CFP:
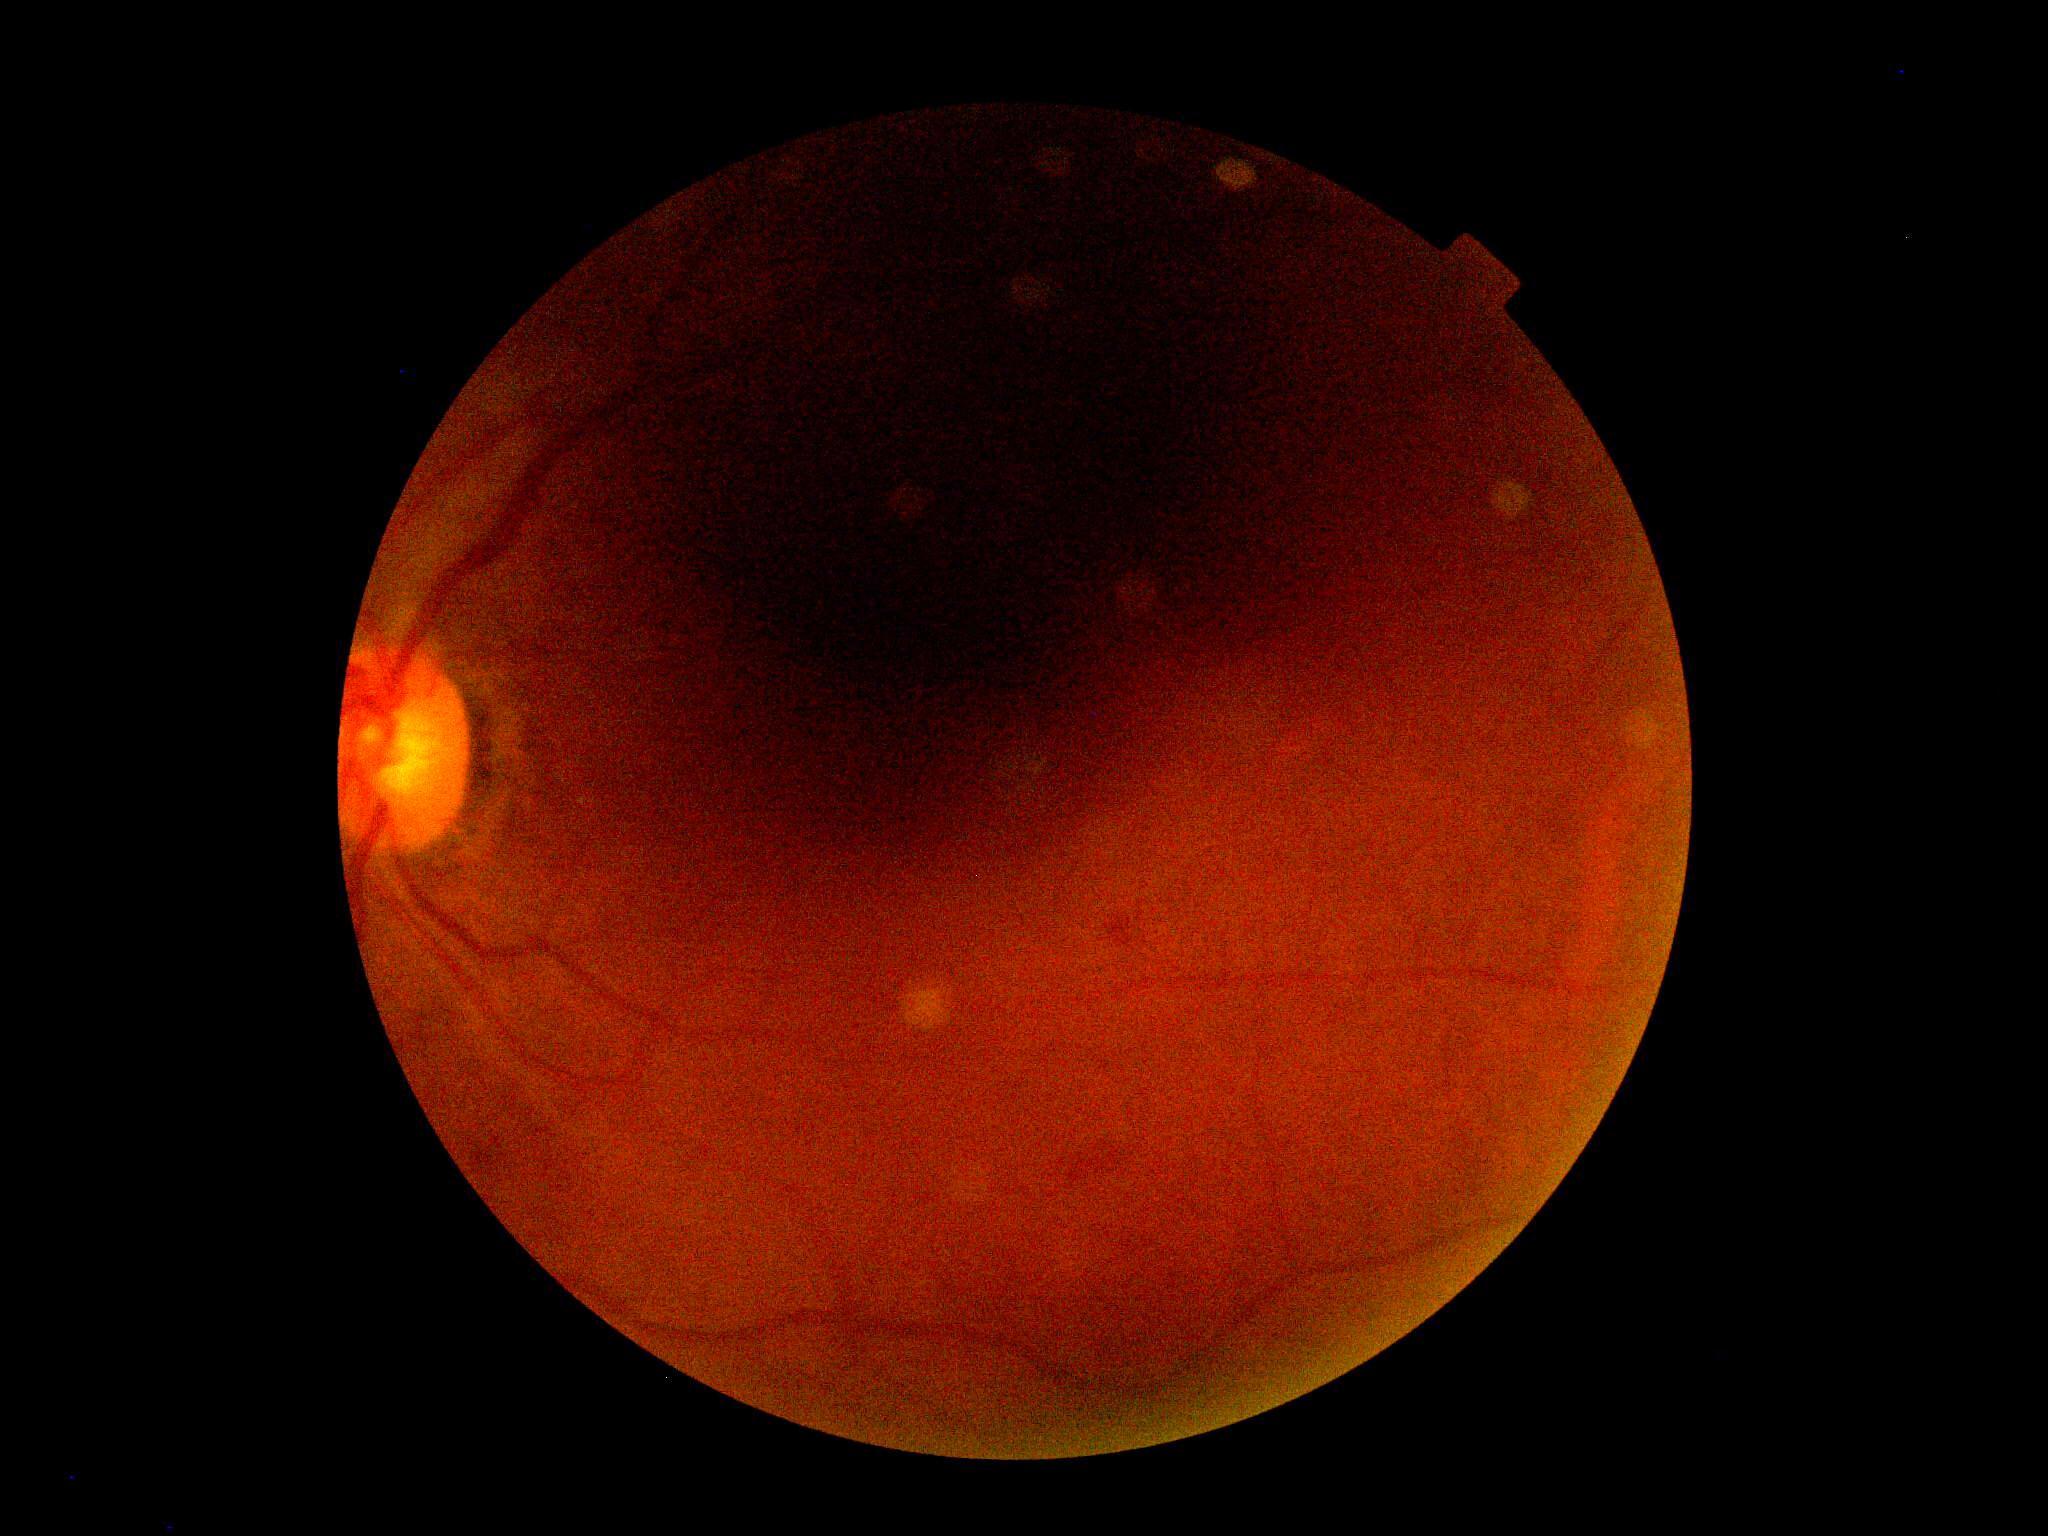

DR grade: ungradable due to poor image quality; image quality: below grading threshold.